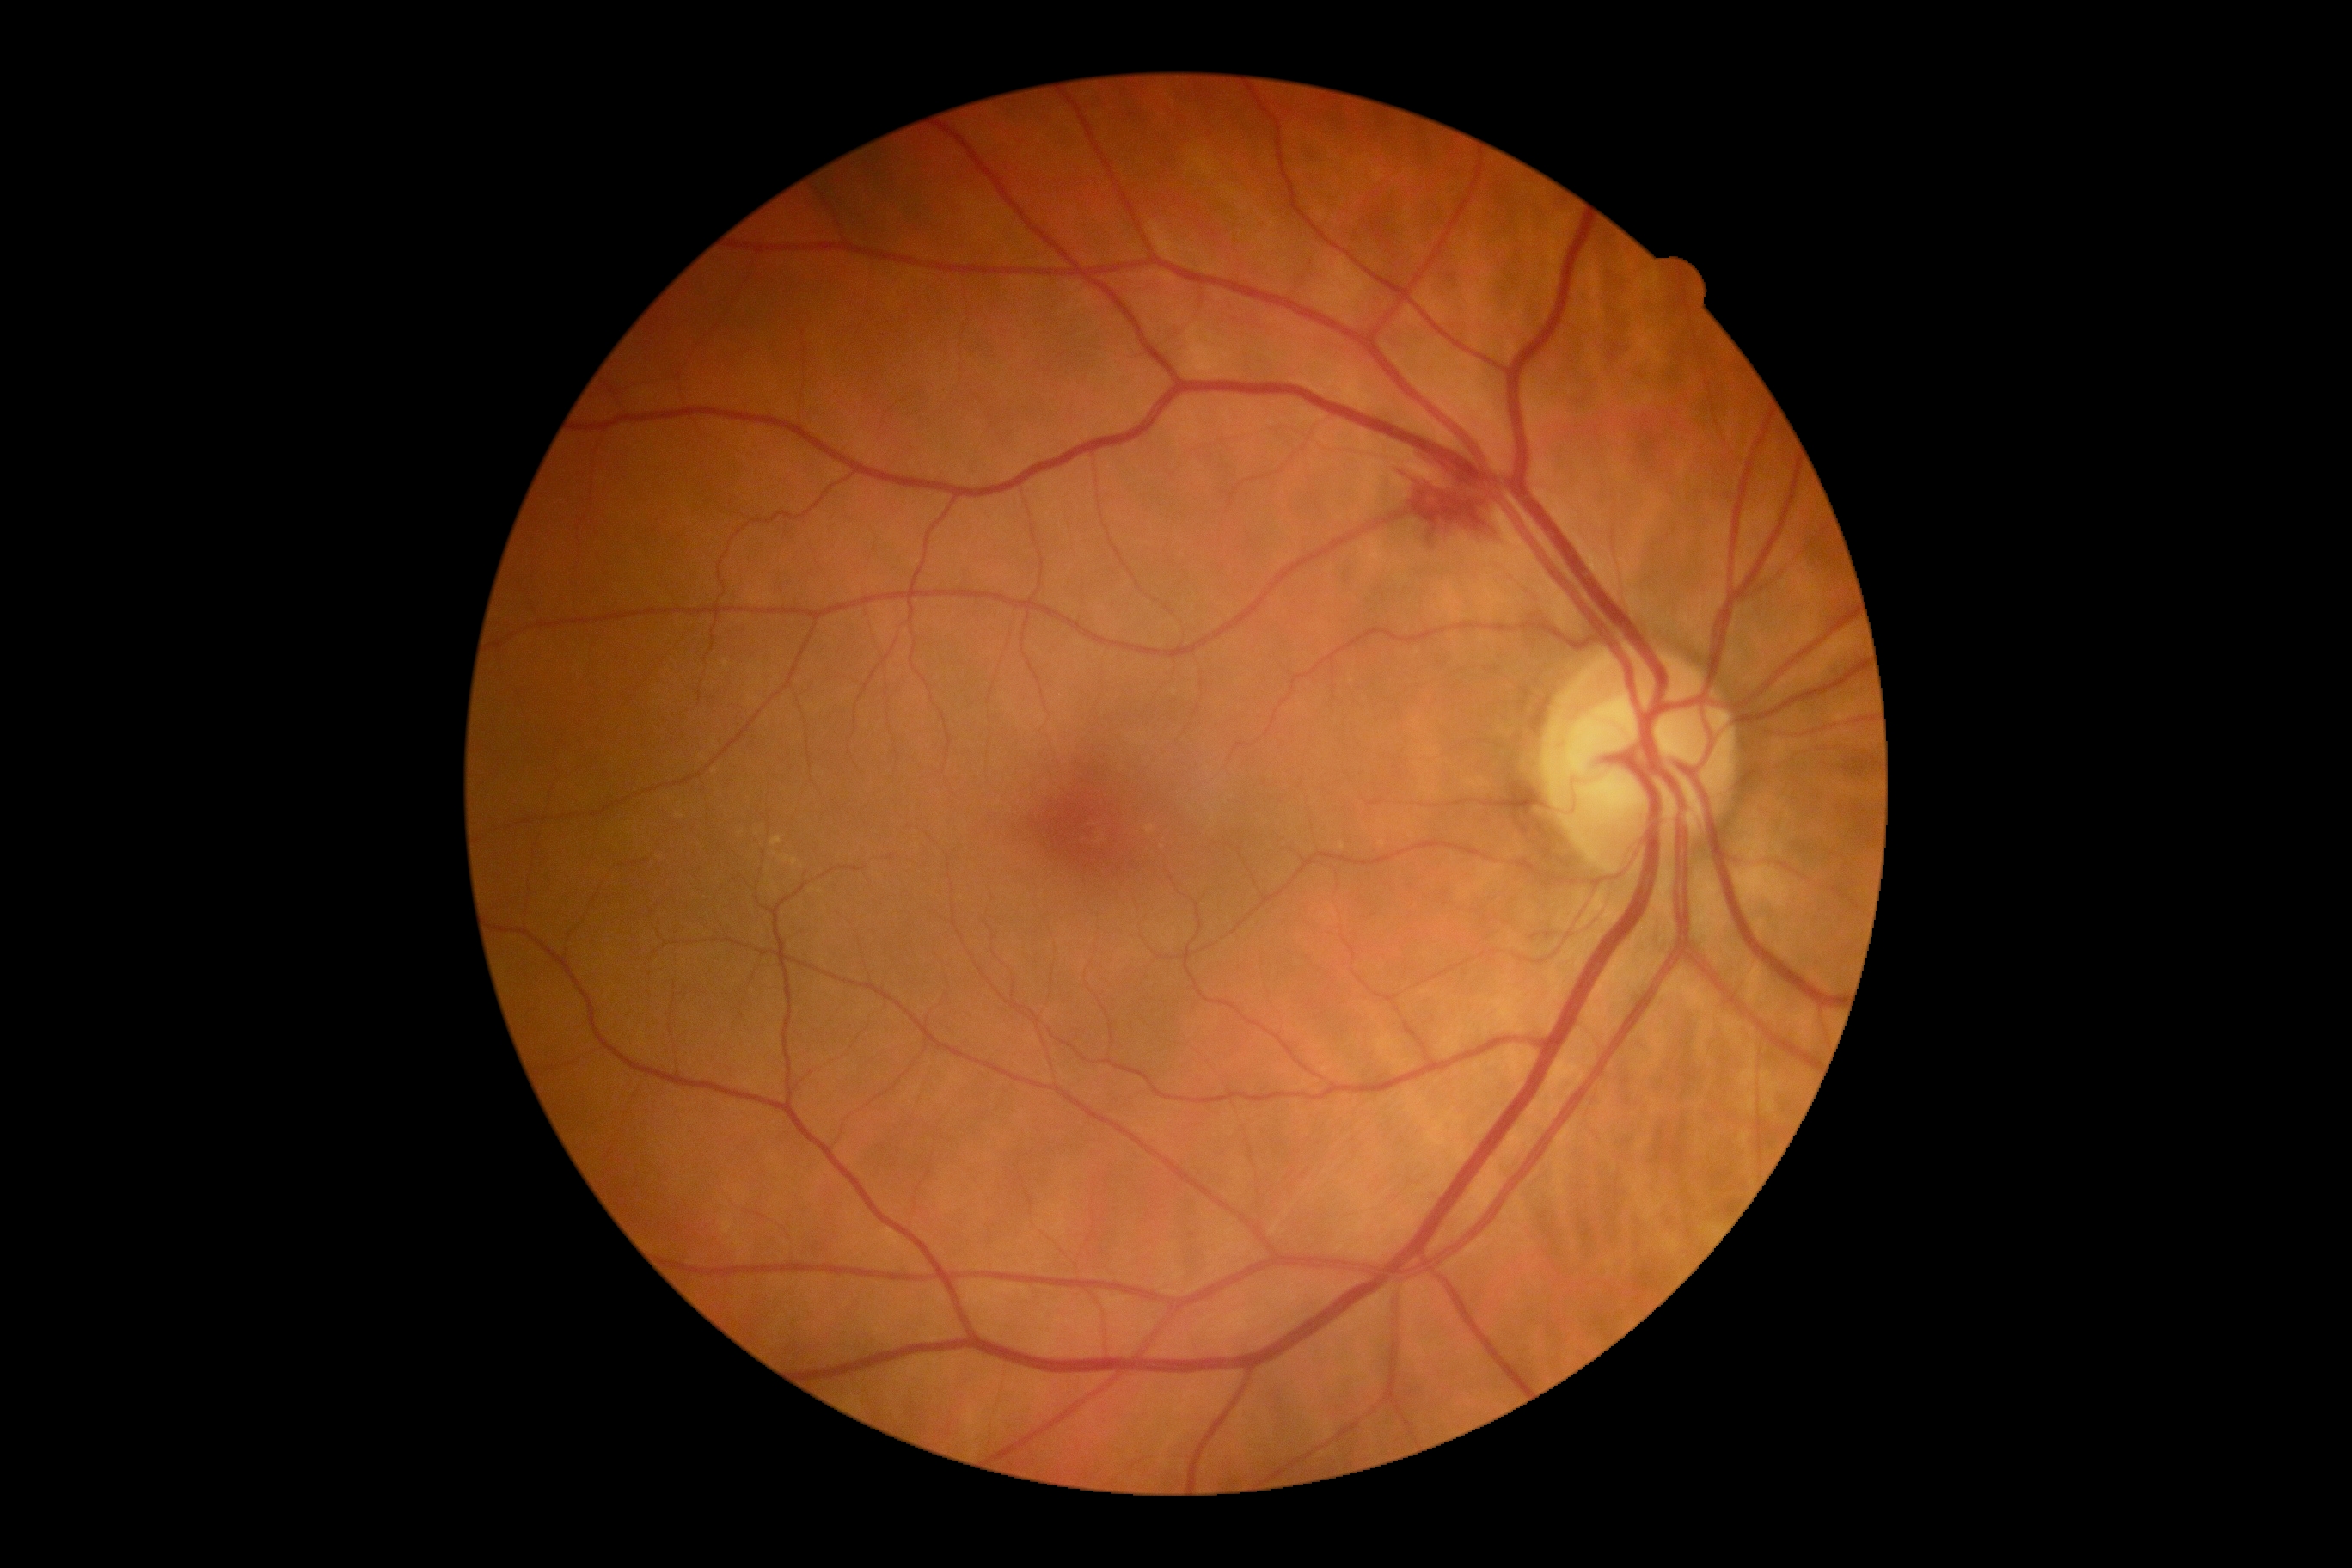 diabetic retinopathy severity = moderate non-proliferative diabetic retinopathy (grade 2).